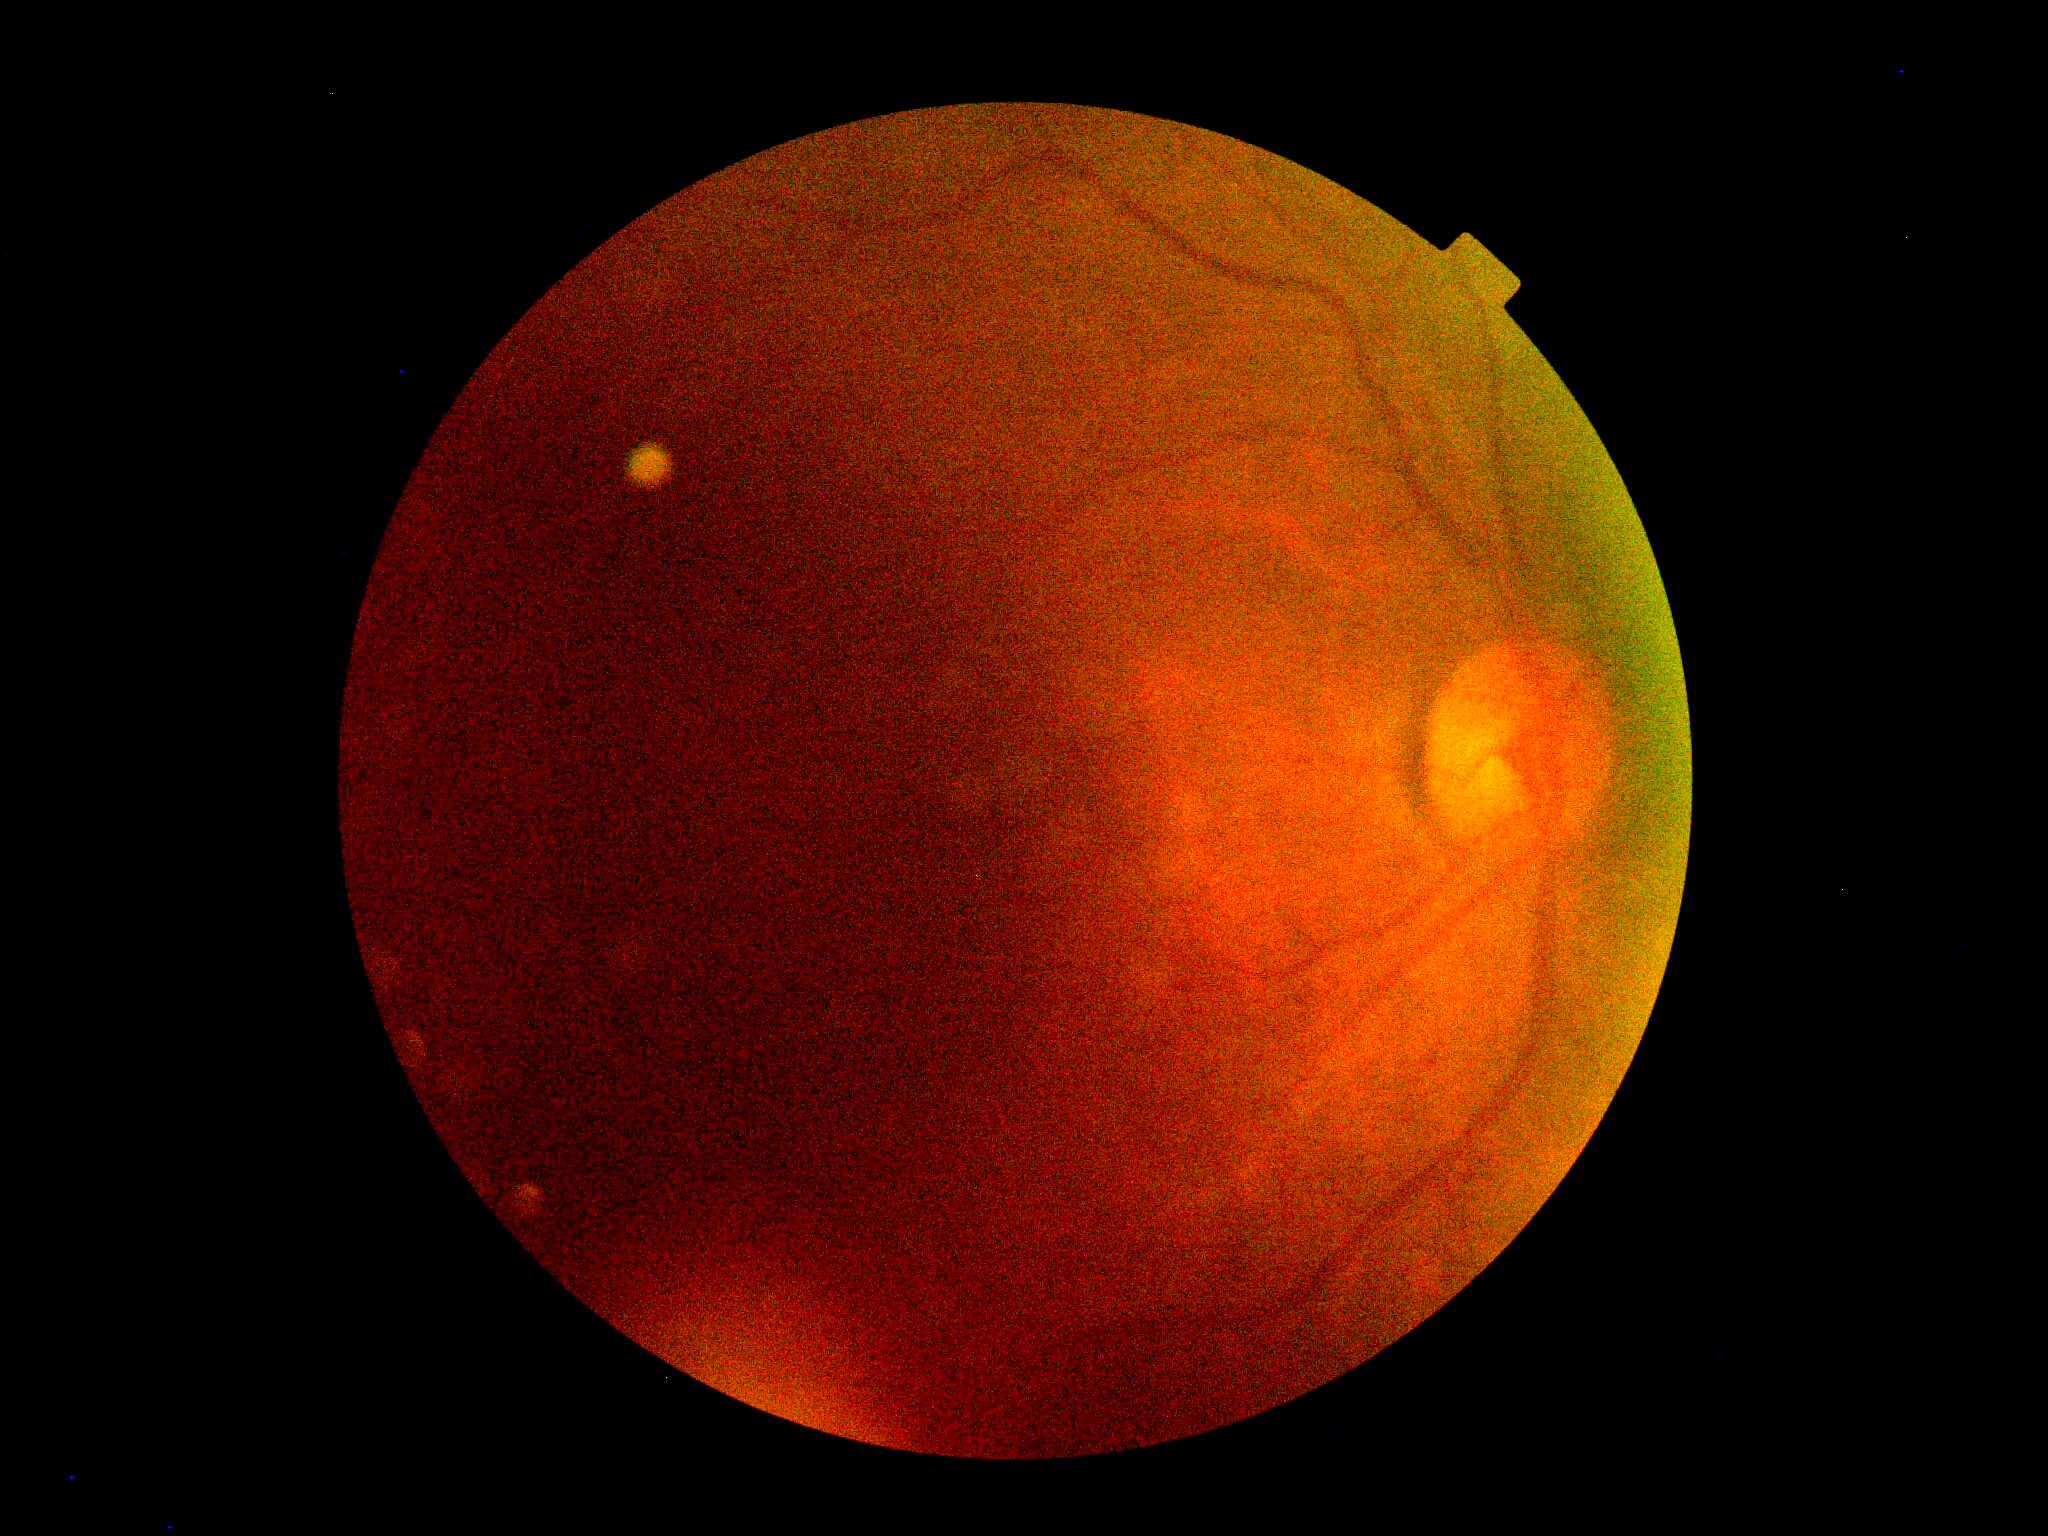
DR grade: ungradable due to poor image quality.